1659x2212. Acquired with a Remidio smartphone fundus camera. Fundus photo: 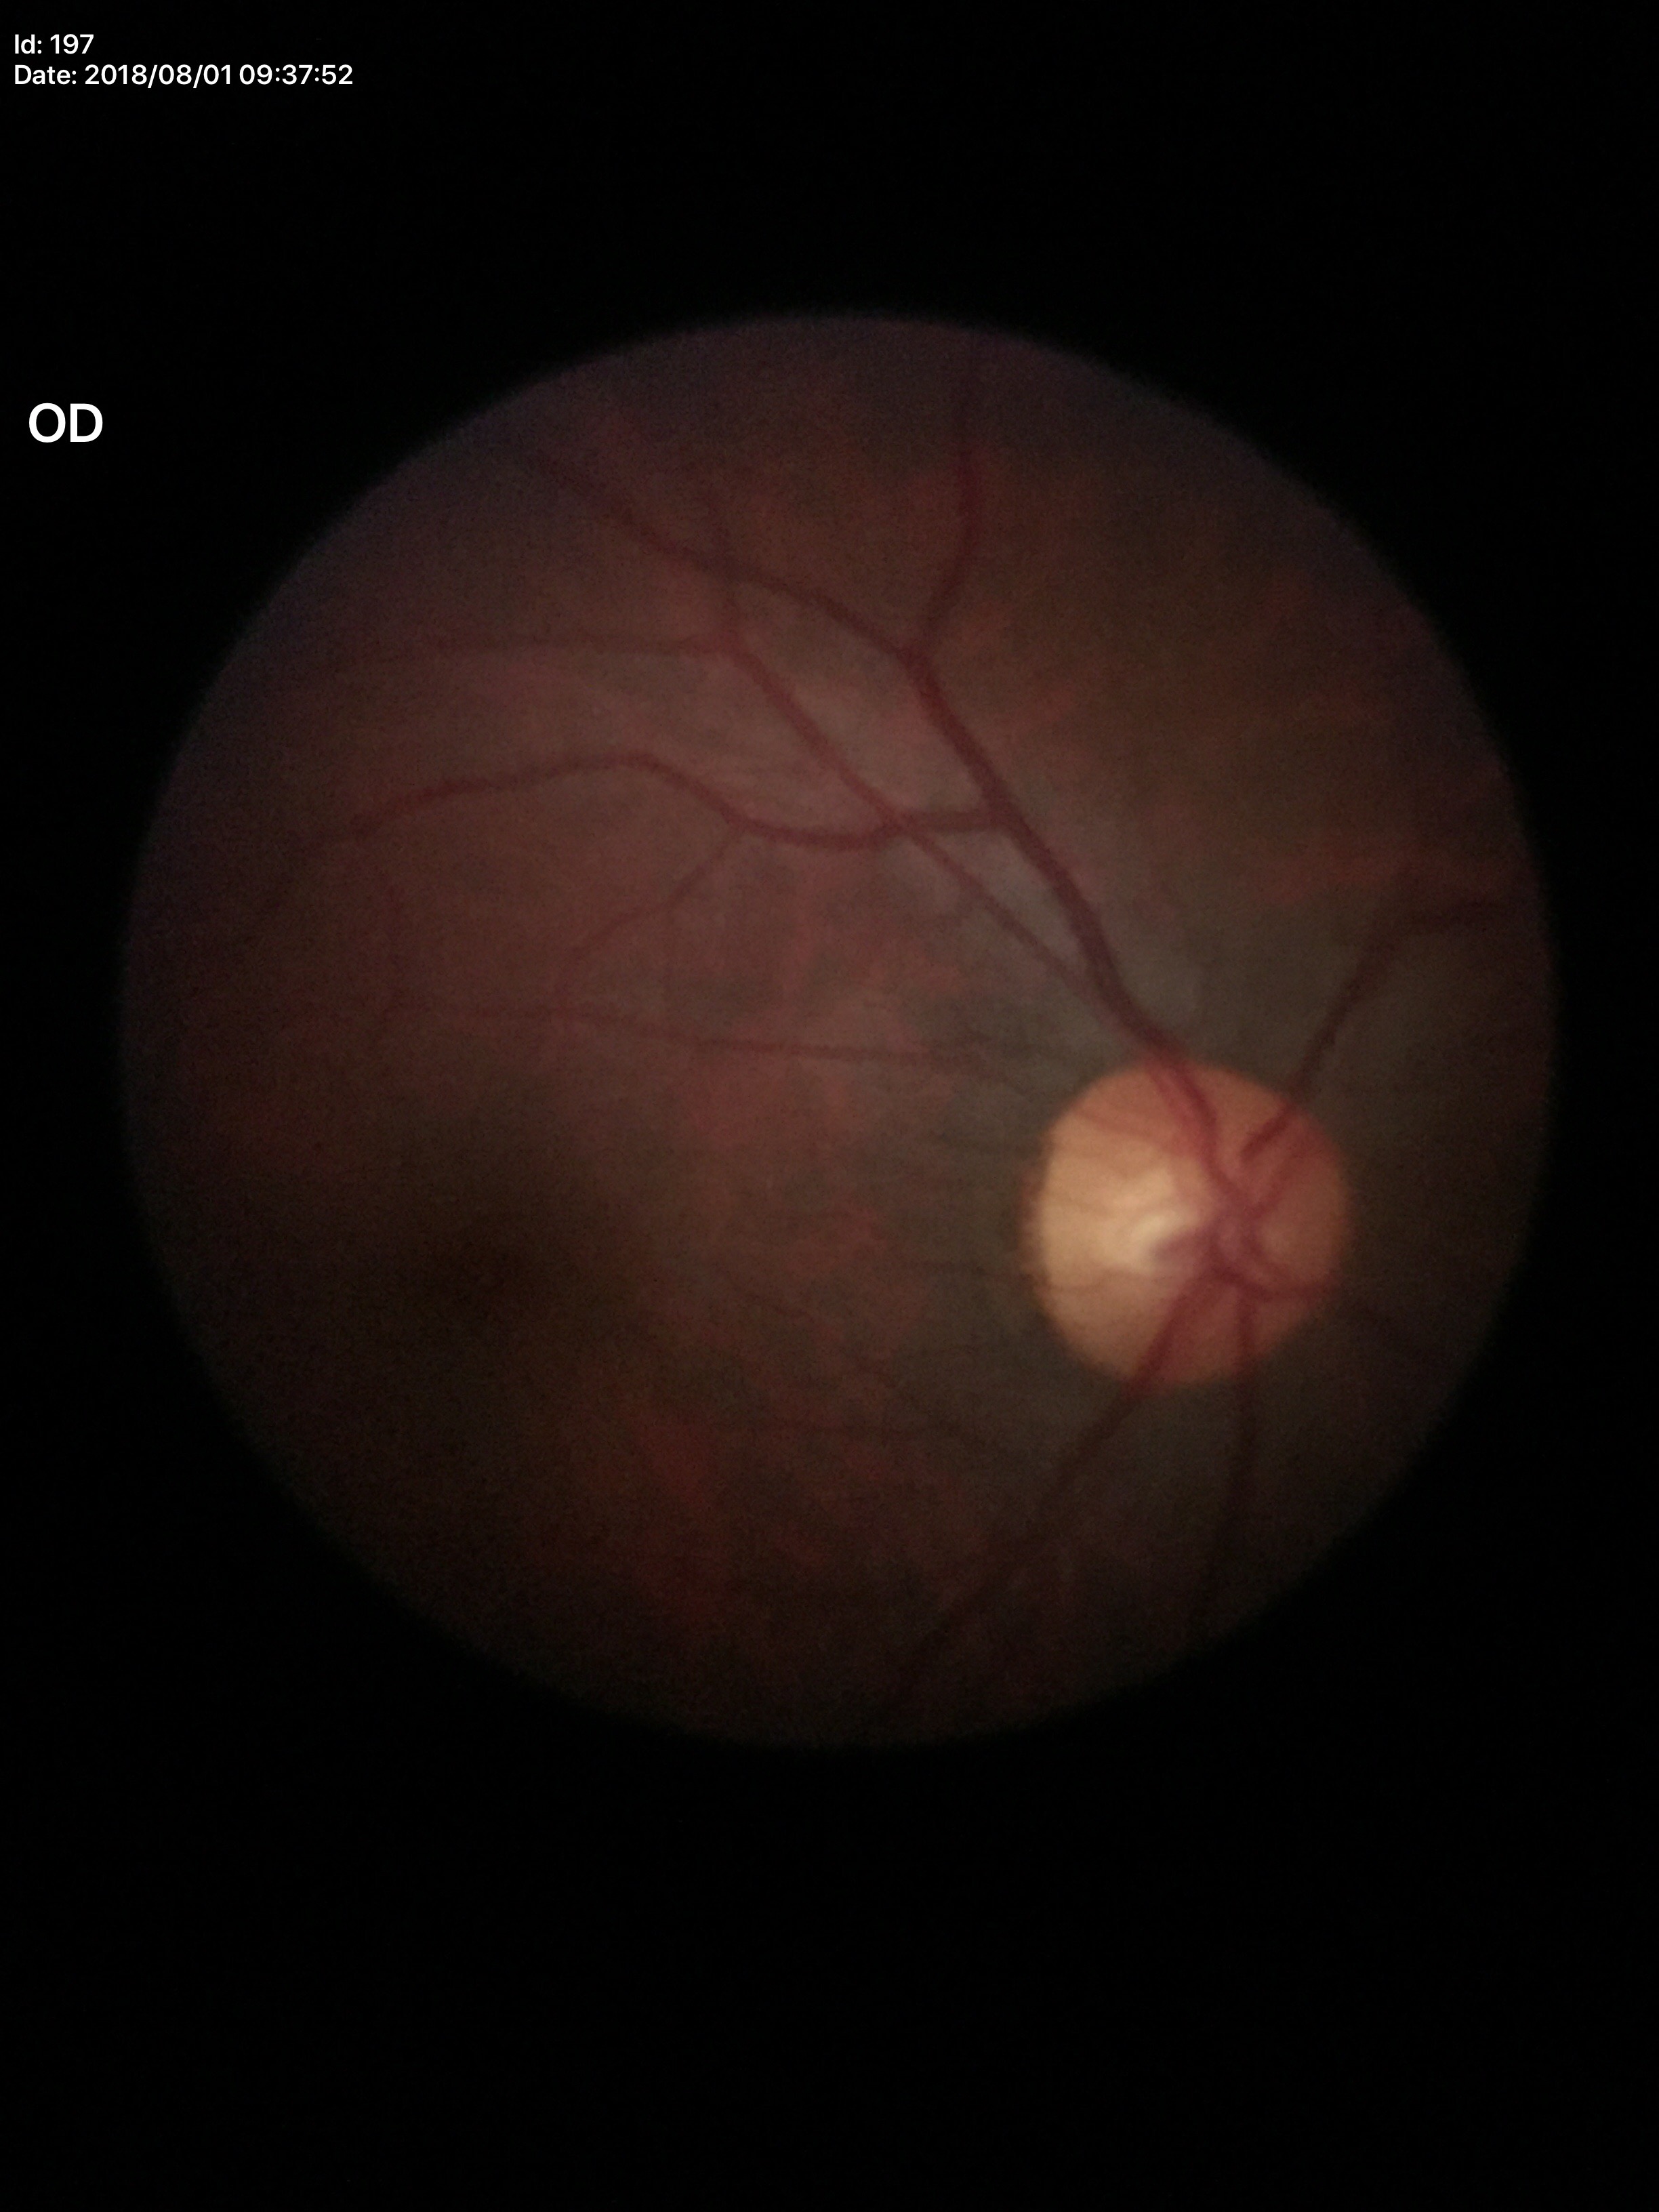

Vertical cup-disc ratio (VCDR): 0.49.
Horizontal cup-disc ratio (HCDR) of 0.53.
Glaucoma decision: negative.